Pediatric retinal photograph (wide-field); 130° field of view (Clarity RetCam 3) — 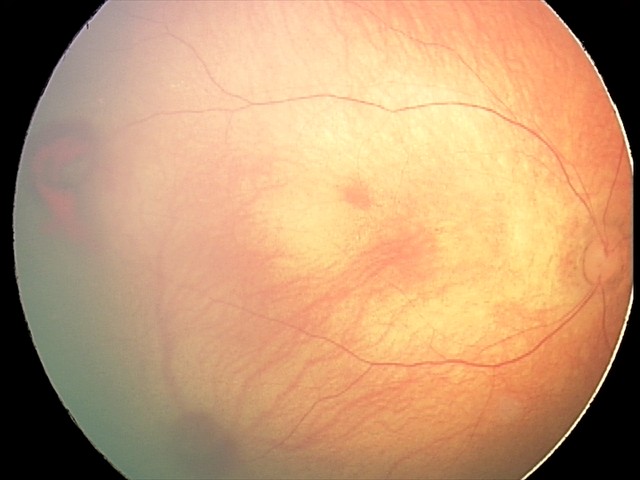 Screening: retinal hemorrhages.